Retinal fundus photograph: 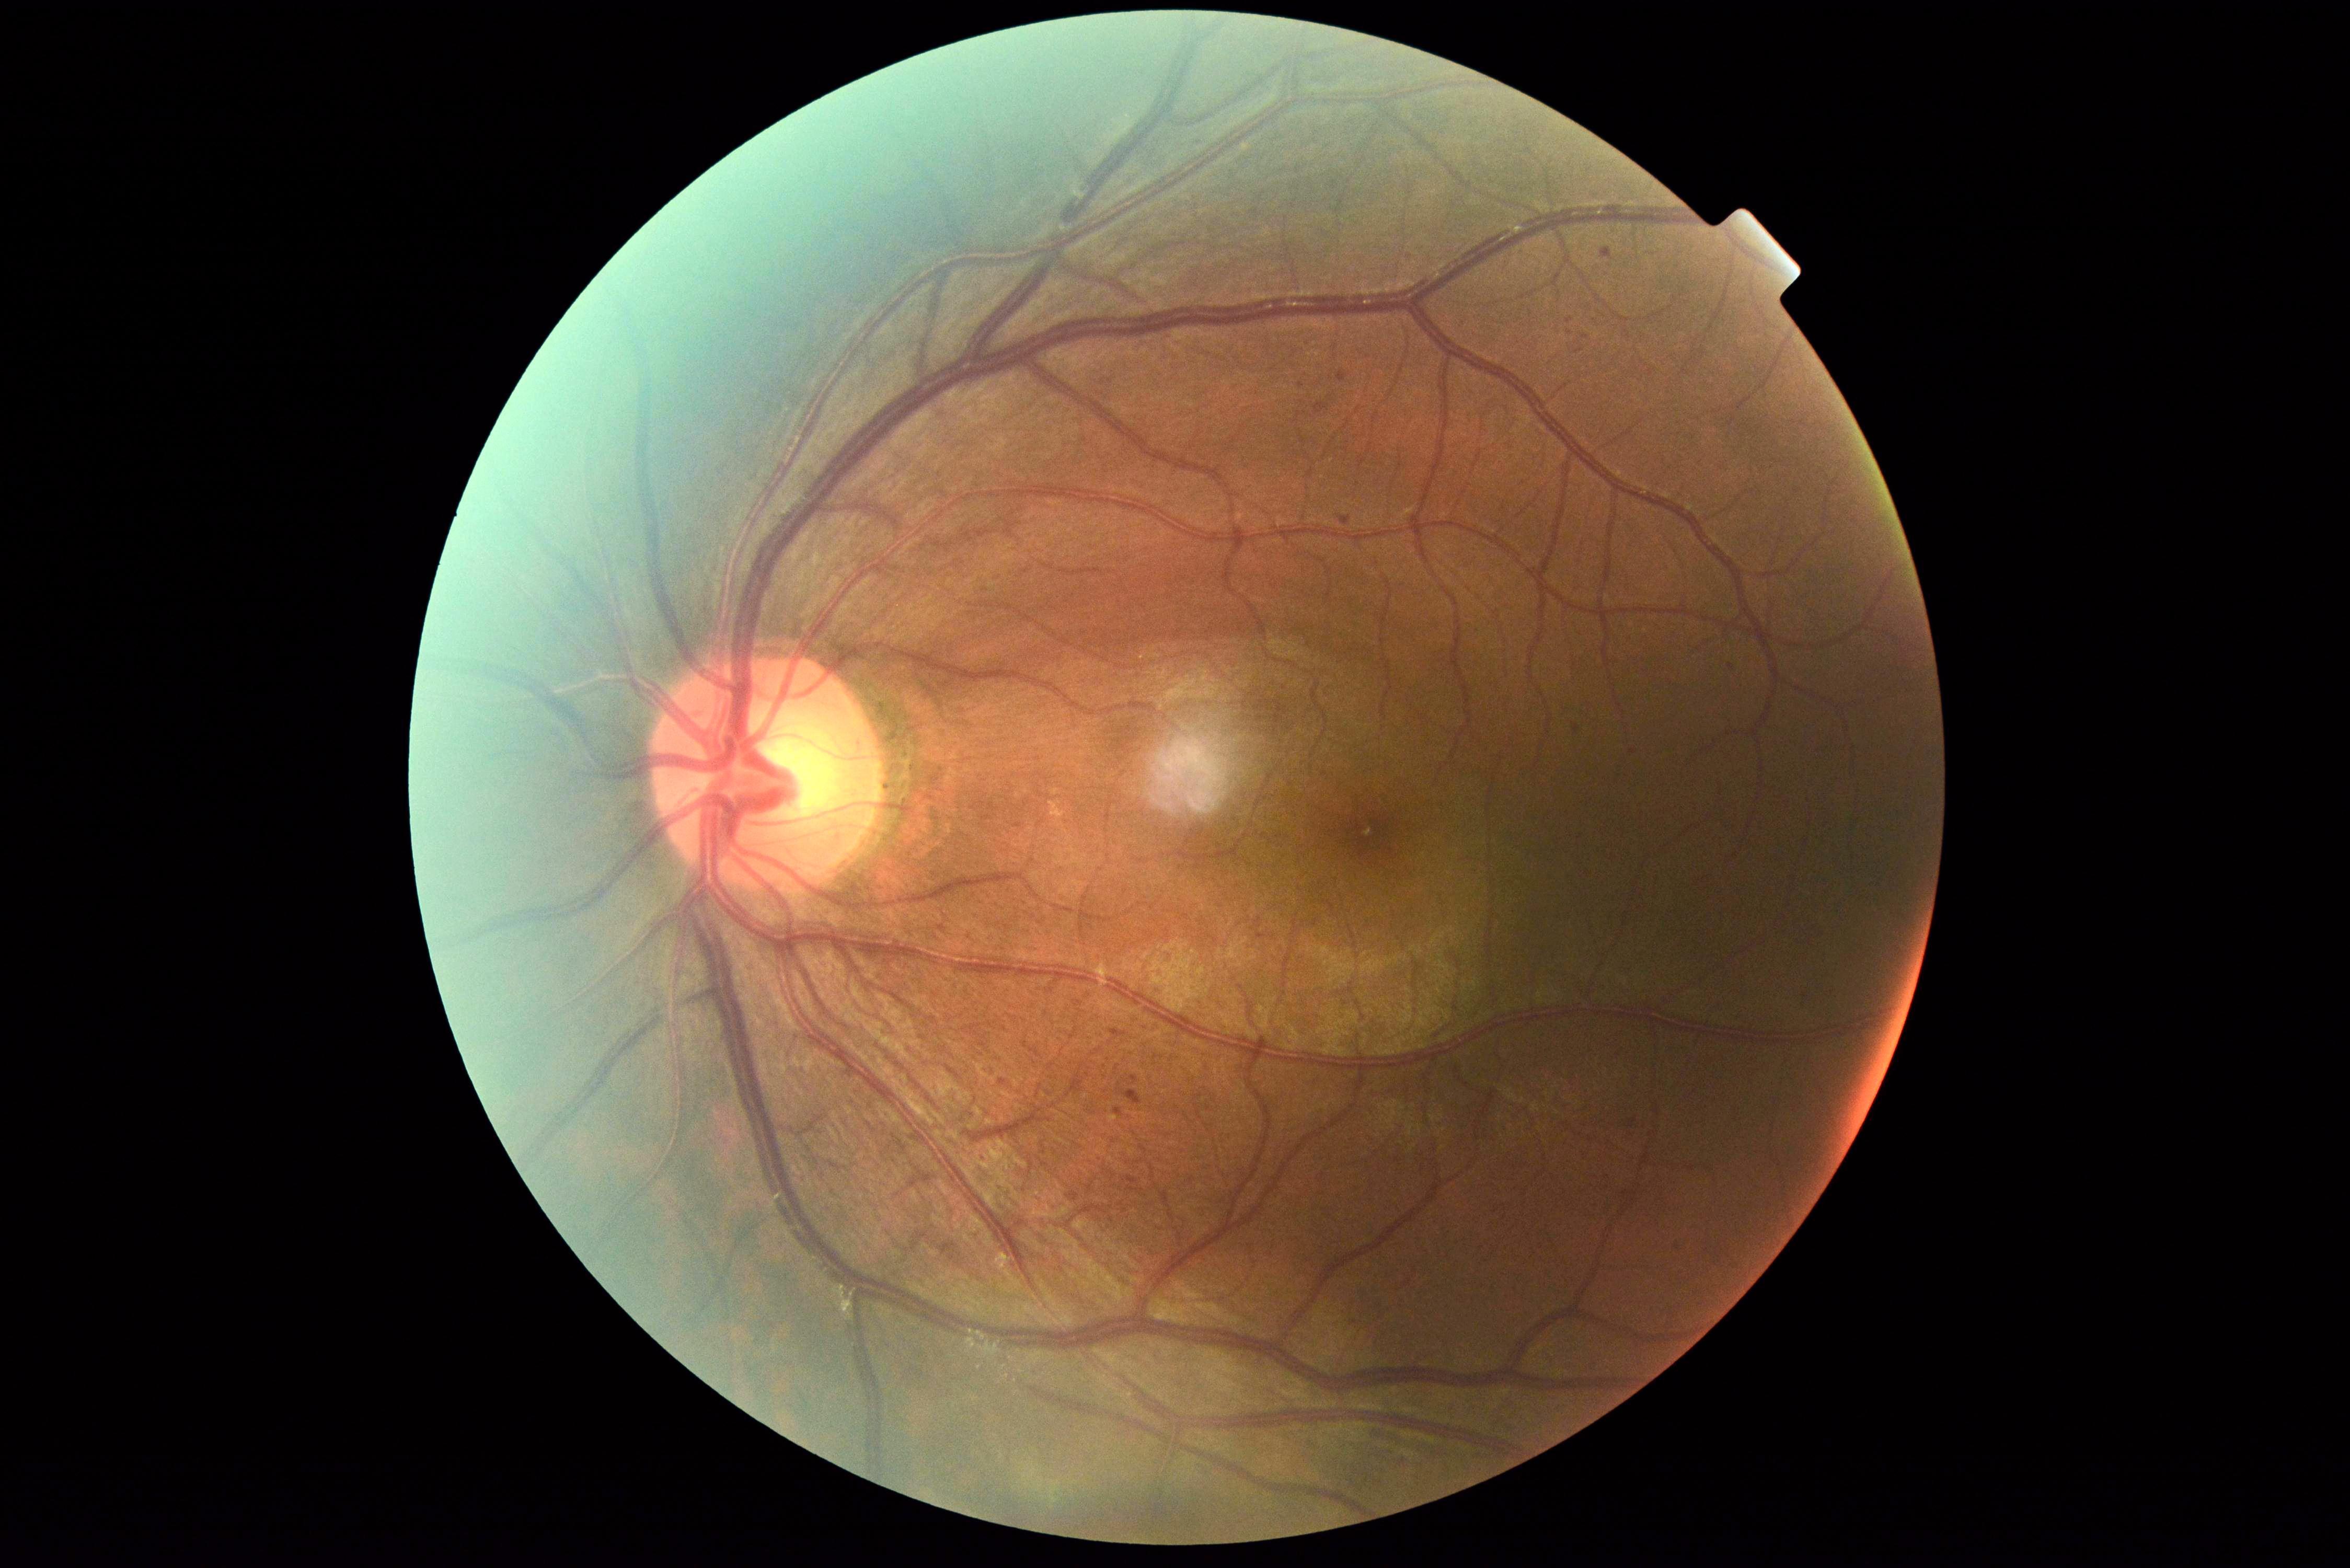 {"dr_grade": "grade 1"}